45-degree field of view, color fundus photograph: 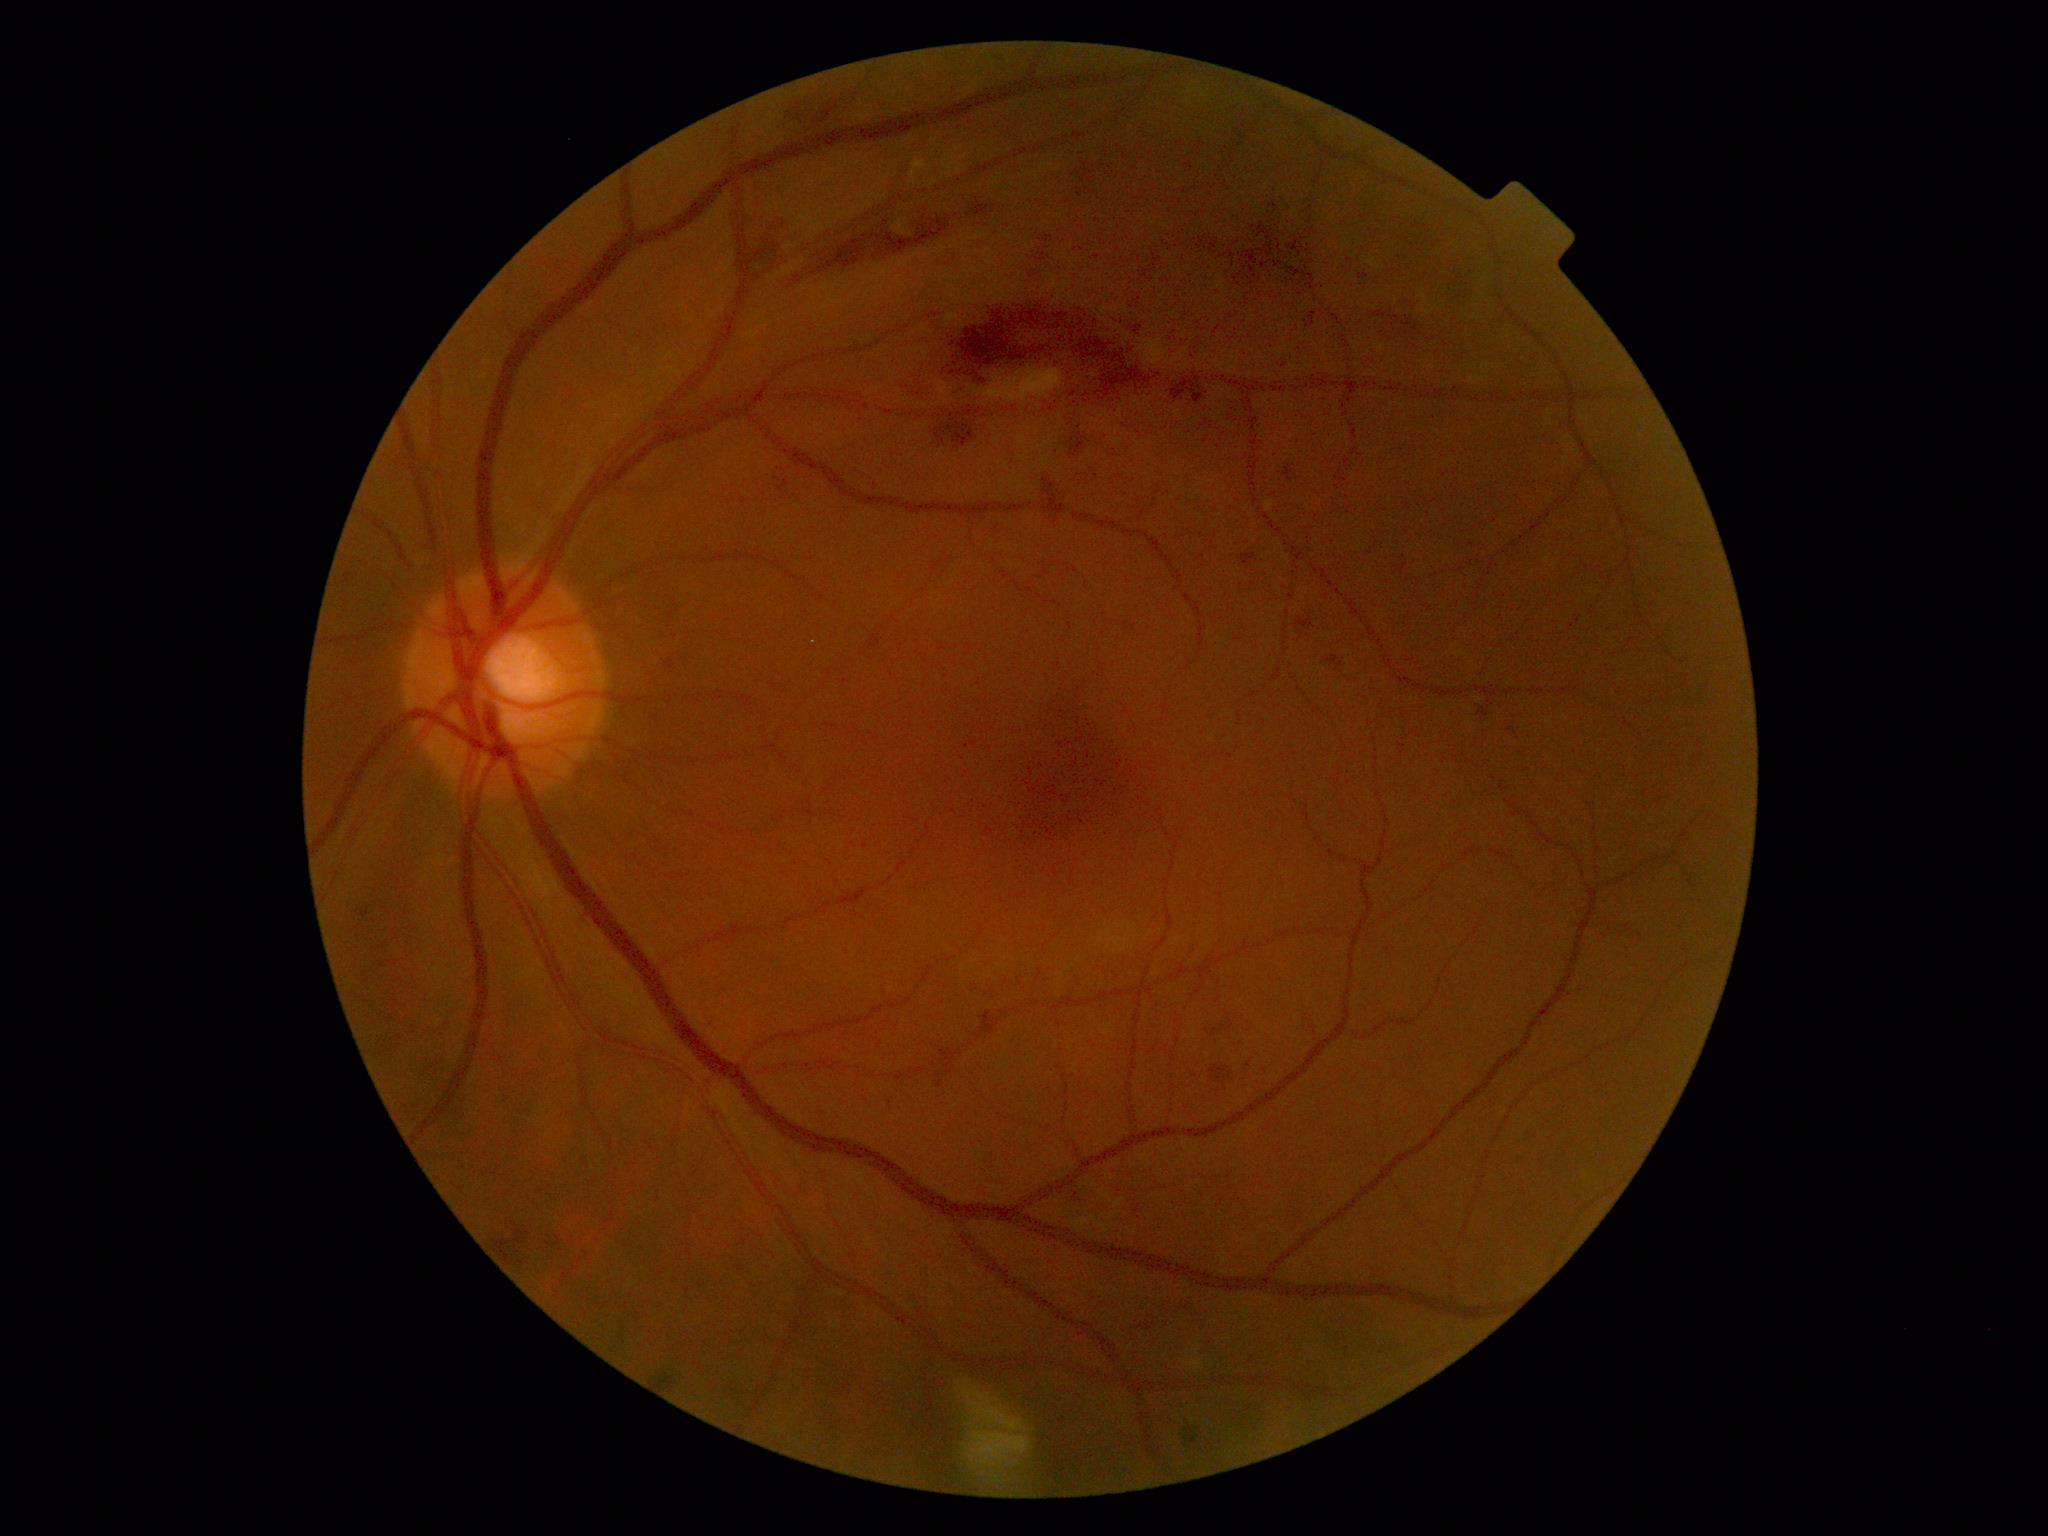
{"dr_grade": "2/4"}